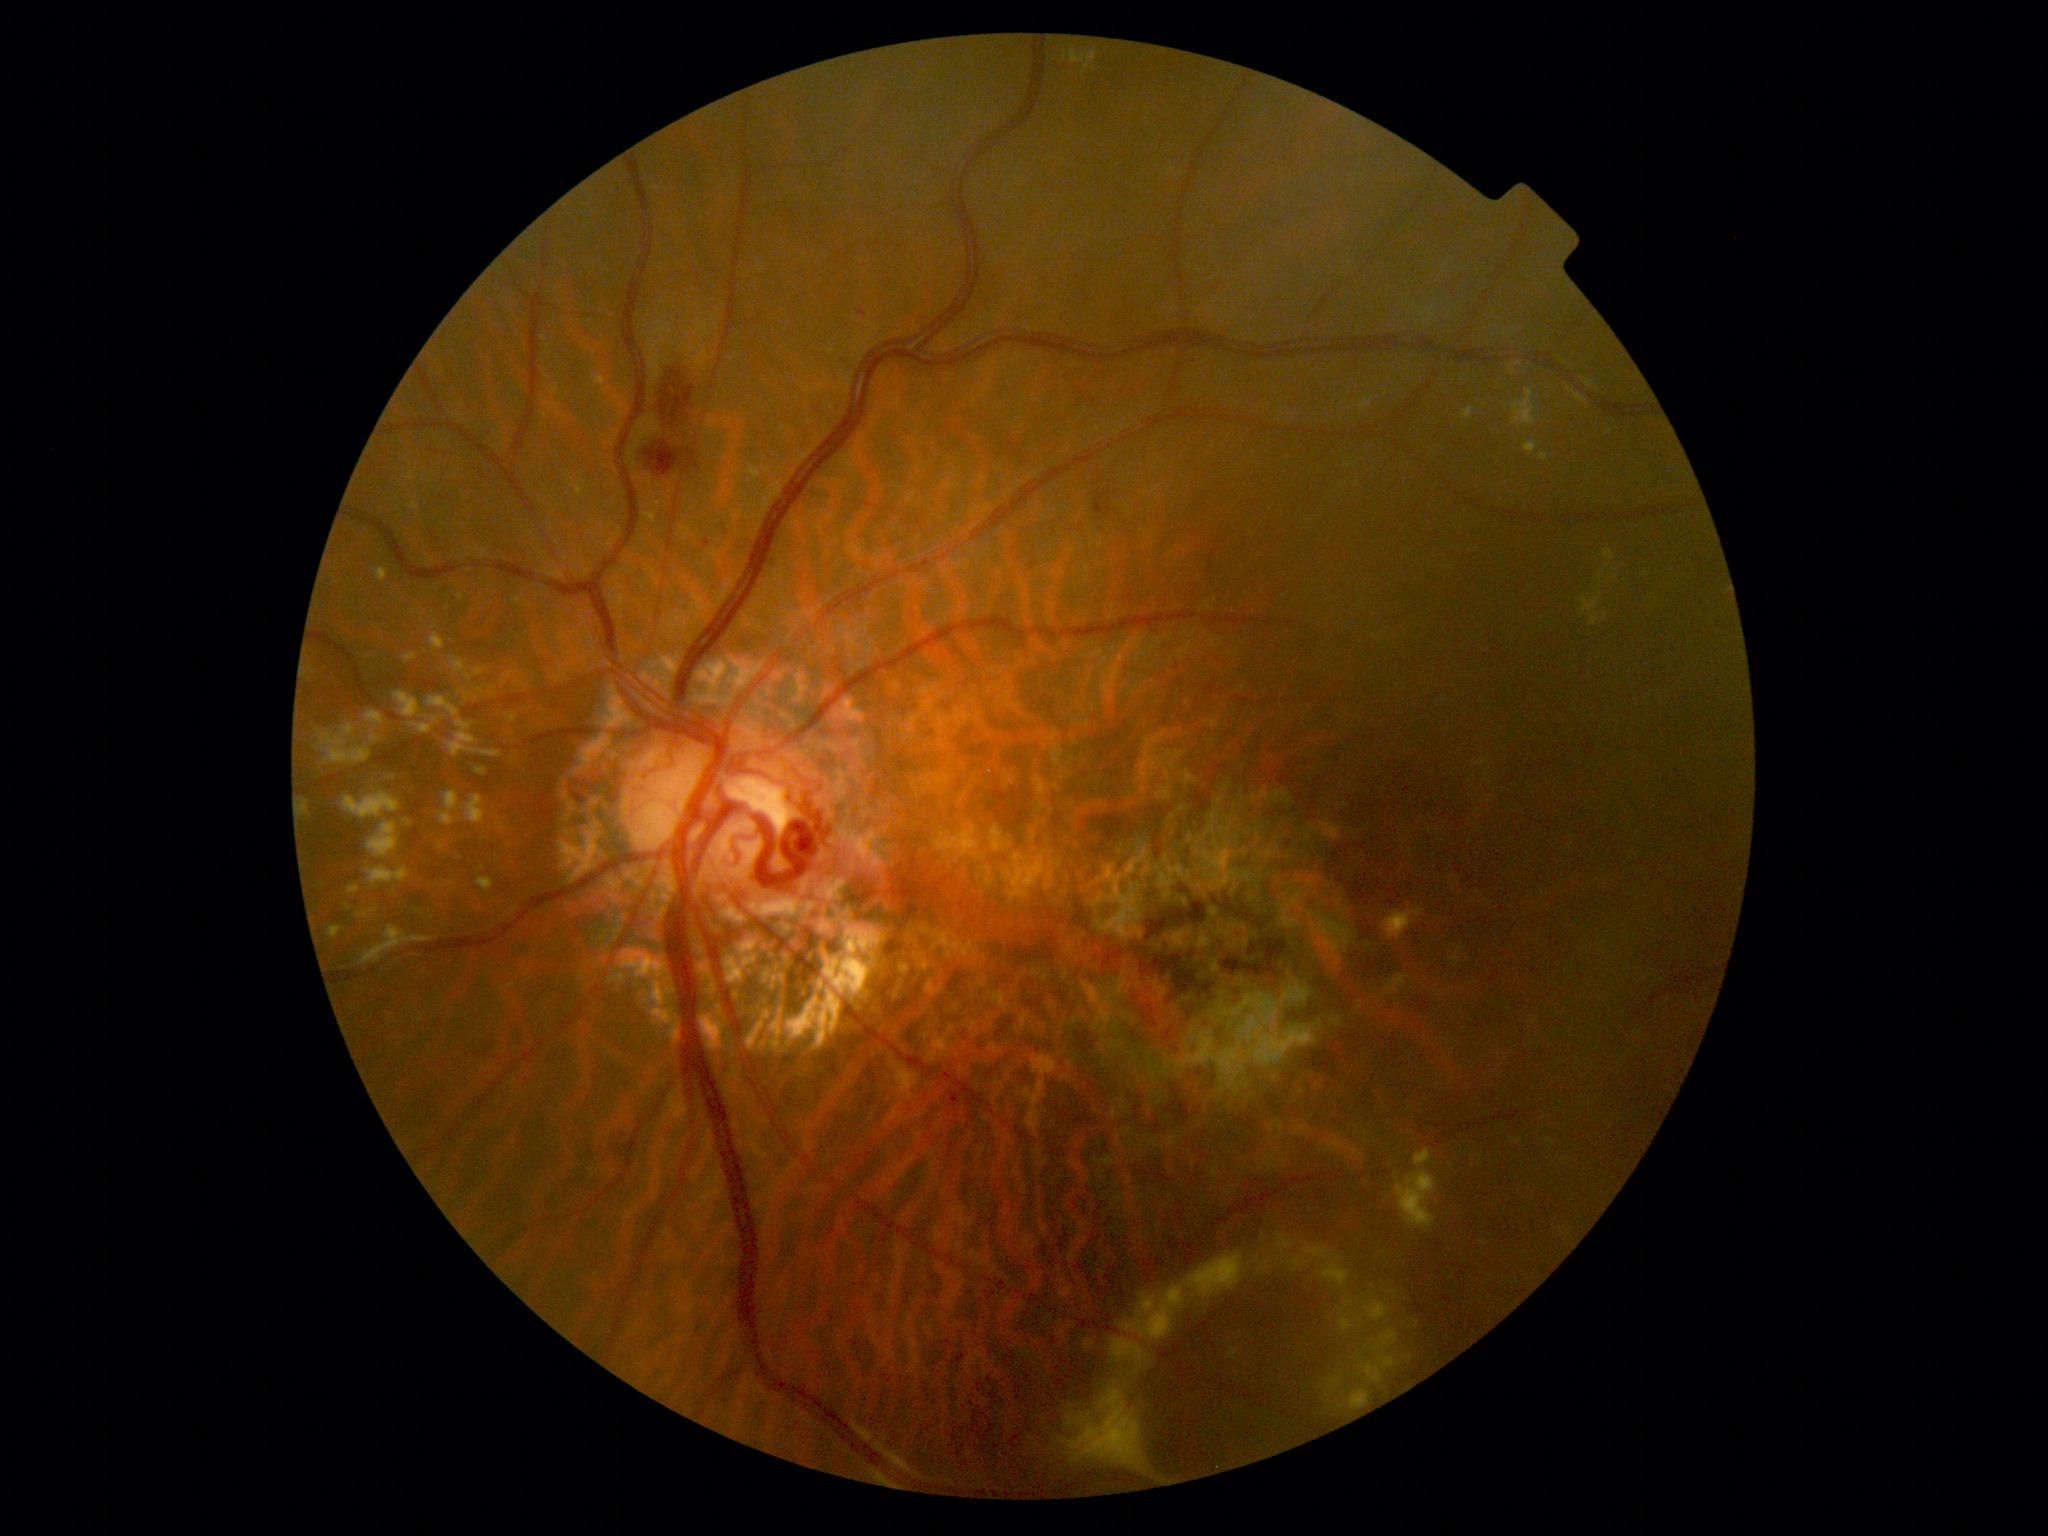 DR severity: grade 2
Lesions identified (partial list):
EXs (more not shown): bbox(1196, 1250, 1252, 1303) | bbox(1540, 452, 1549, 461) | bbox(403, 653, 417, 663) | bbox(1509, 365, 1516, 375) | bbox(1582, 596, 1602, 616) | bbox(450, 745, 497, 759) | bbox(301, 799, 312, 818) | bbox(1350, 1389, 1371, 1410) | bbox(1414, 1148, 1433, 1168) | bbox(1365, 1300, 1390, 1322) | bbox(423, 693, 472, 729) | bbox(1110, 1337, 1149, 1366) | bbox(1380, 1356, 1396, 1367) | bbox(1345, 1302, 1354, 1306) | bbox(477, 876, 494, 894) | bbox(1590, 614, 1599, 627) | bbox(451, 735, 487, 742) | bbox(1340, 1316, 1353, 1332)